DR severity per modified Davis staging — 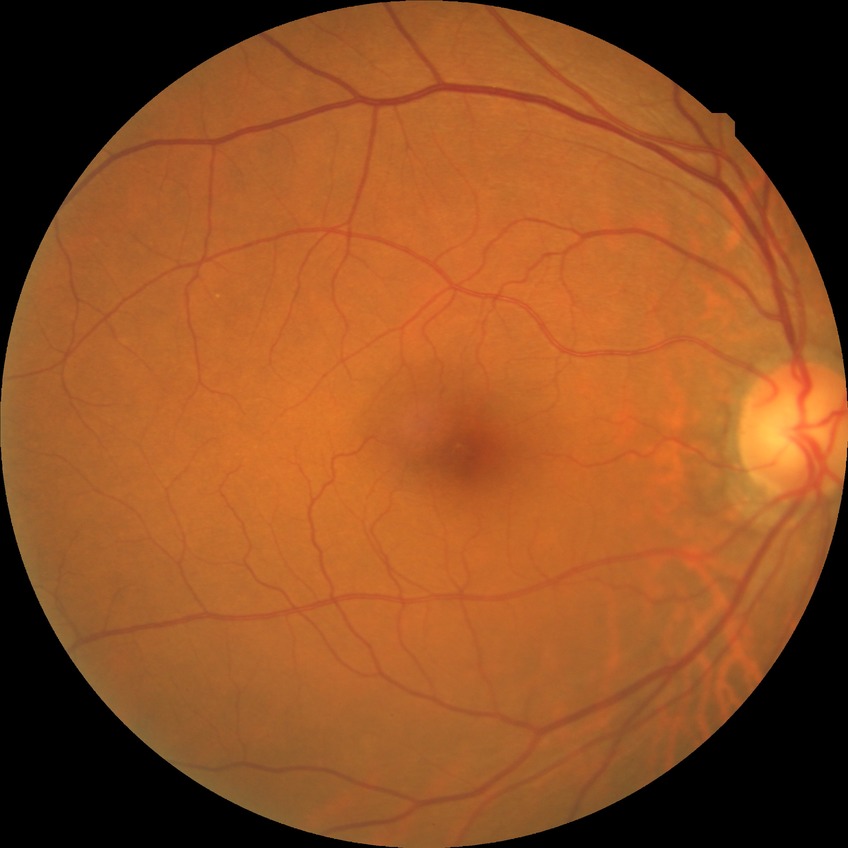
Diabetic retinopathy stage is no diabetic retinopathy.